Nonmydriatic. Image size 848x848. NIDEK AFC-230 — 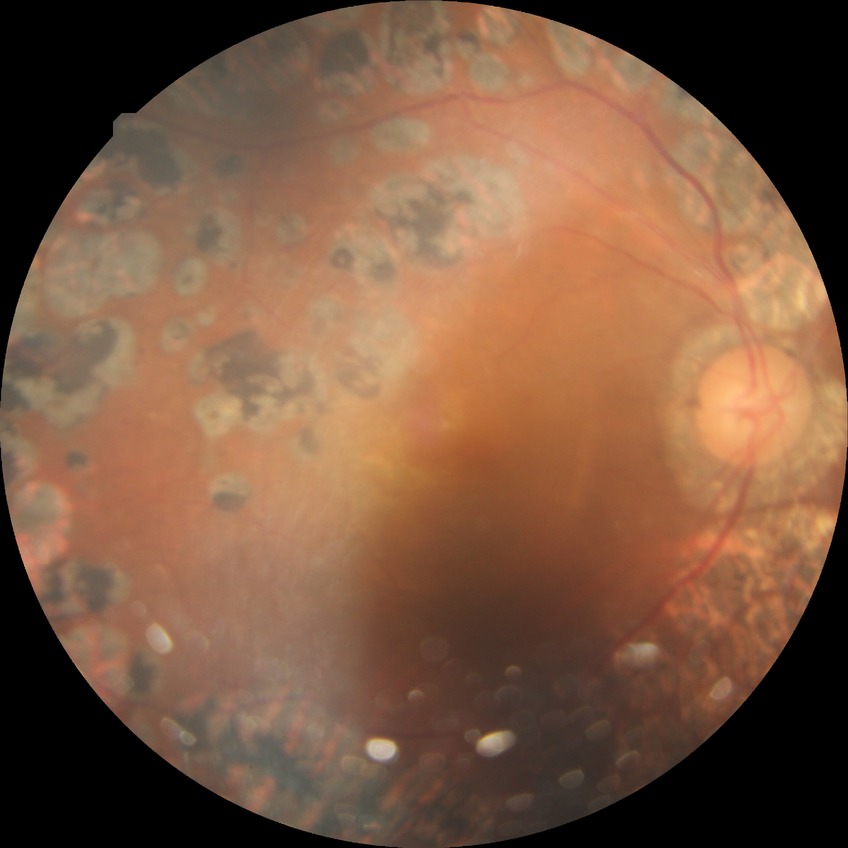 Diabetic retinopathy (DR) is PDR (proliferative diabetic retinopathy).